Ultra-widefield (UWF) fundus image: 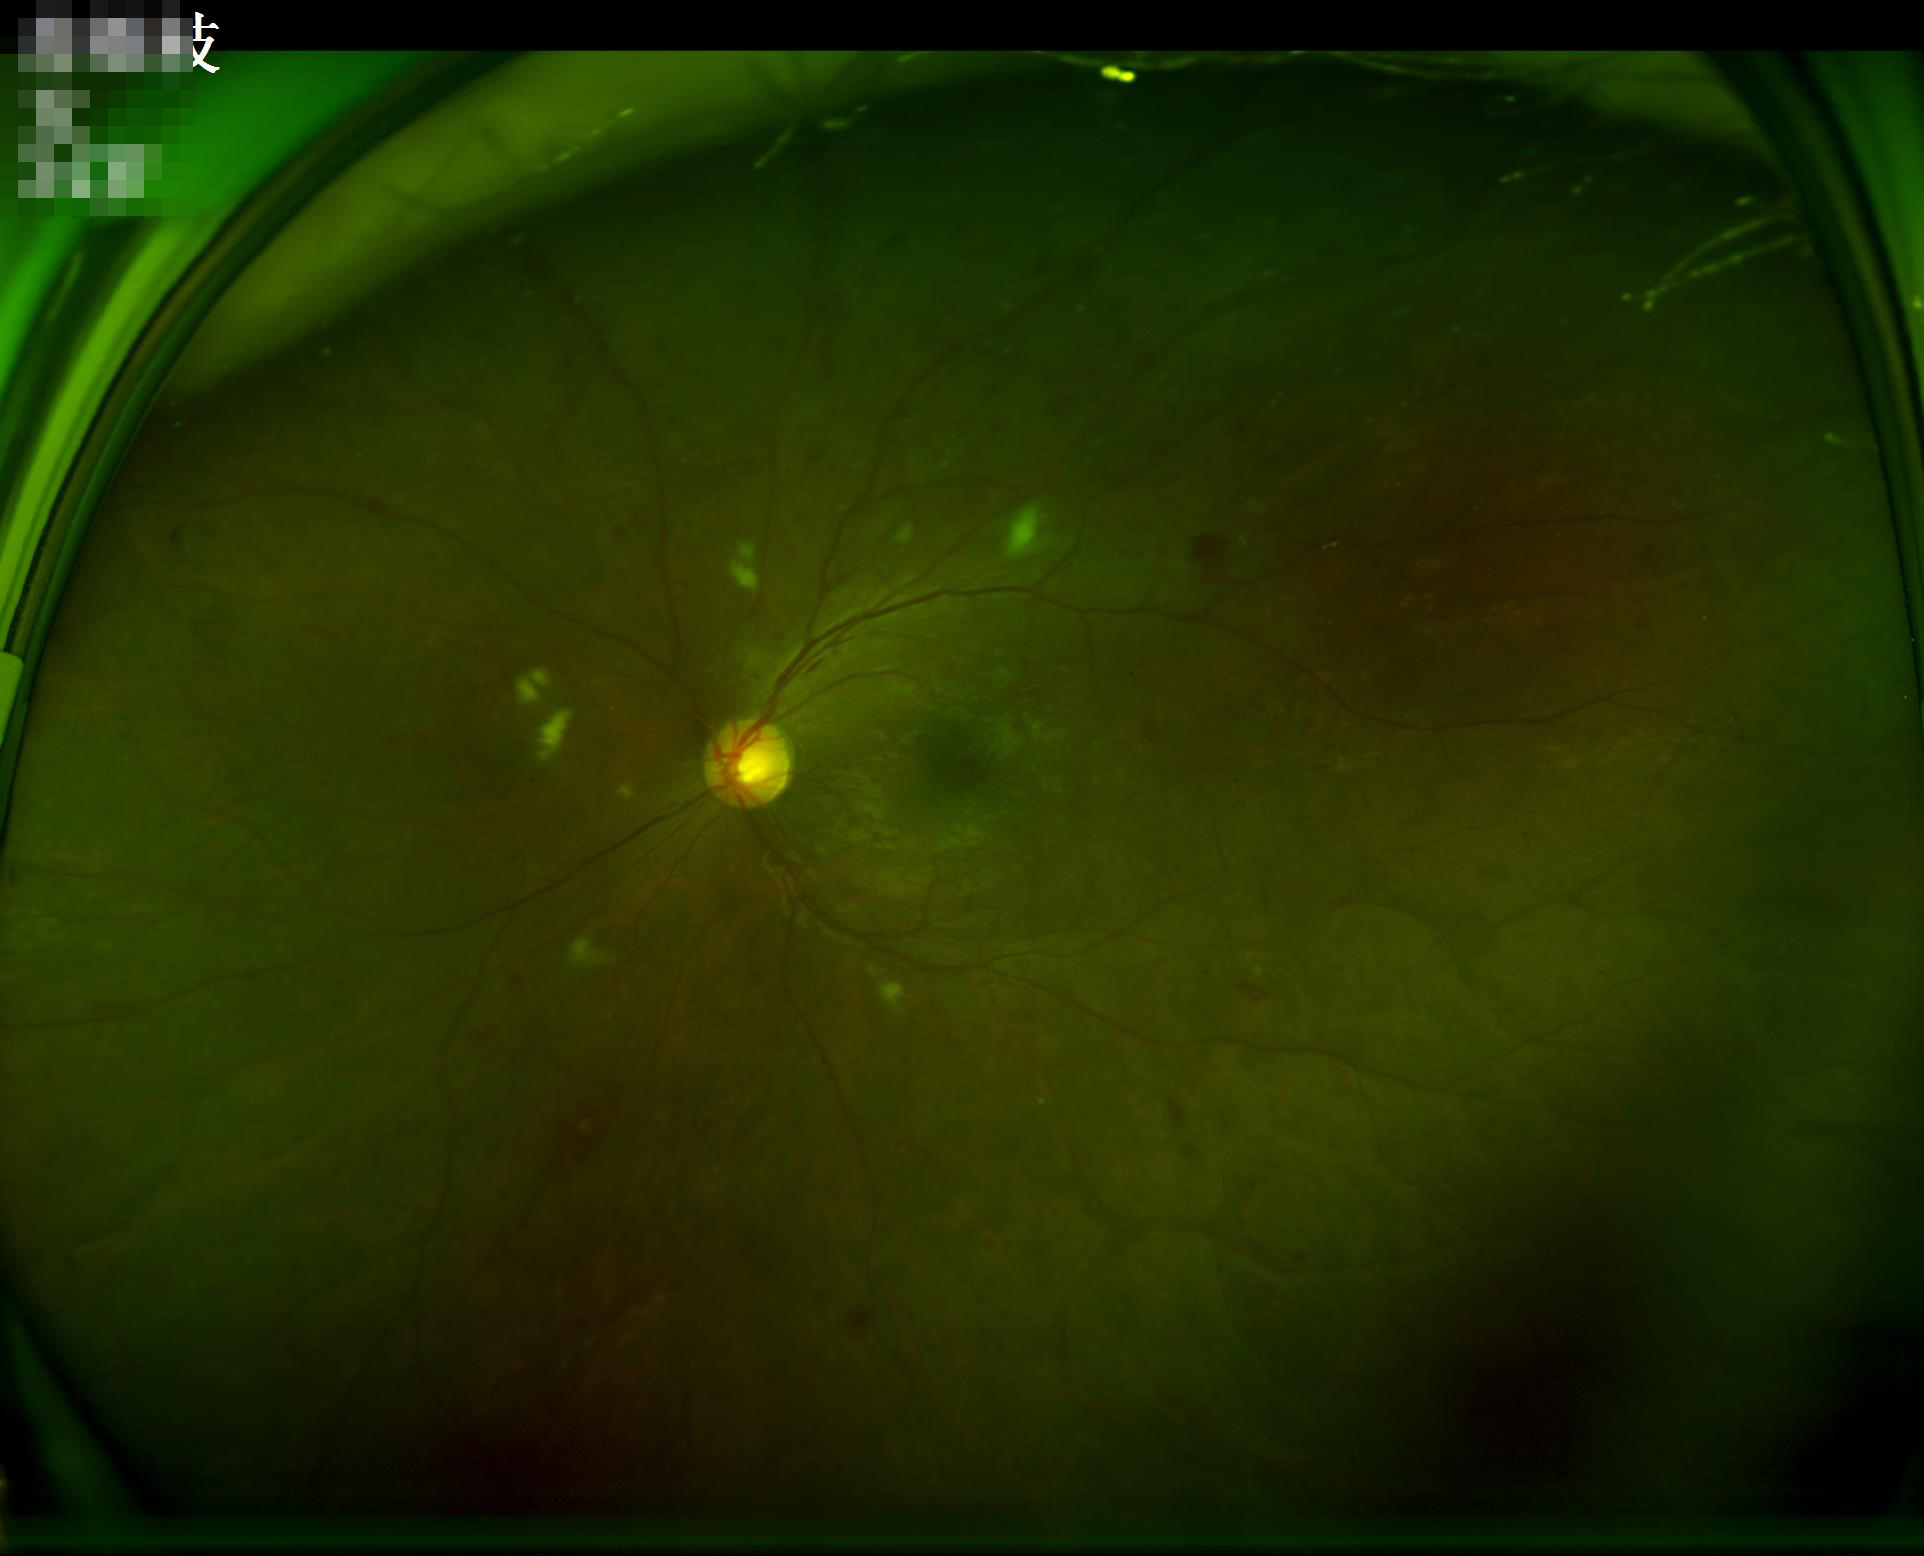

Illumination and color balance are good.
Image quality is adequate for diagnostic use.
Image is sharp throughout the field.
Adequate contrast for distinguishing structures.